2212 x 1659 pixels: 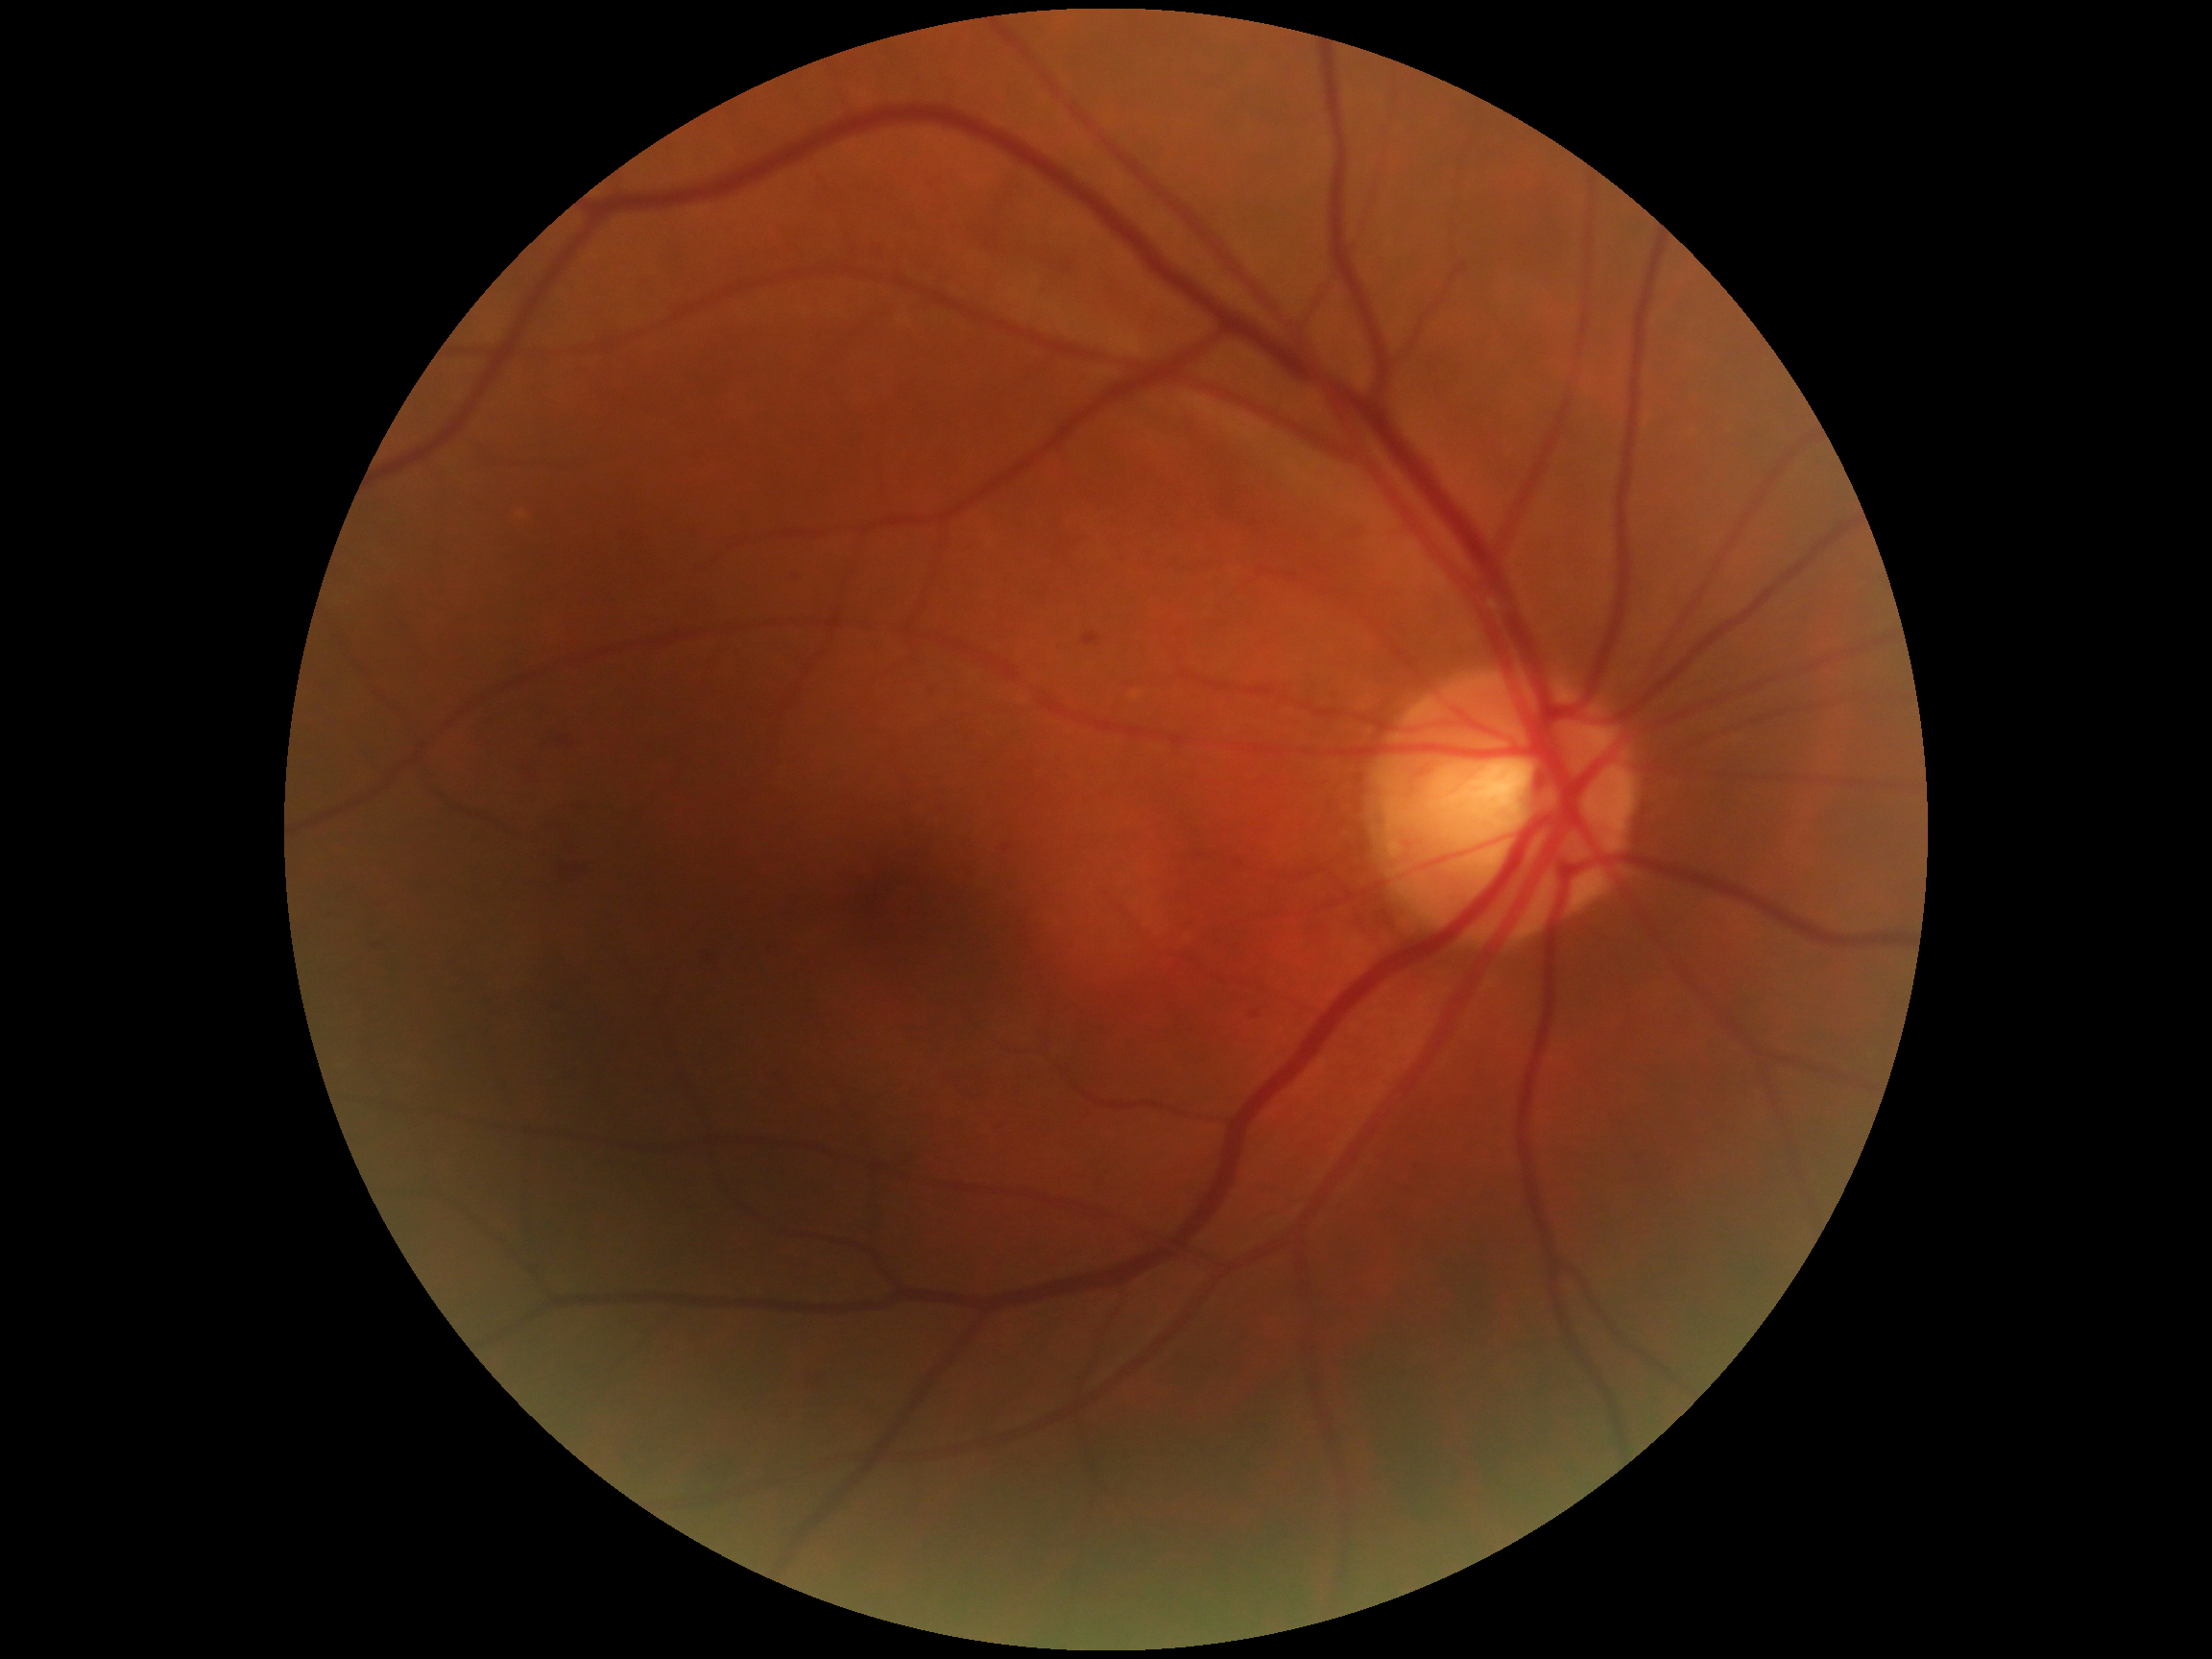 DR severity: grade 2.